Fundus photo. Image size 1932x1916.
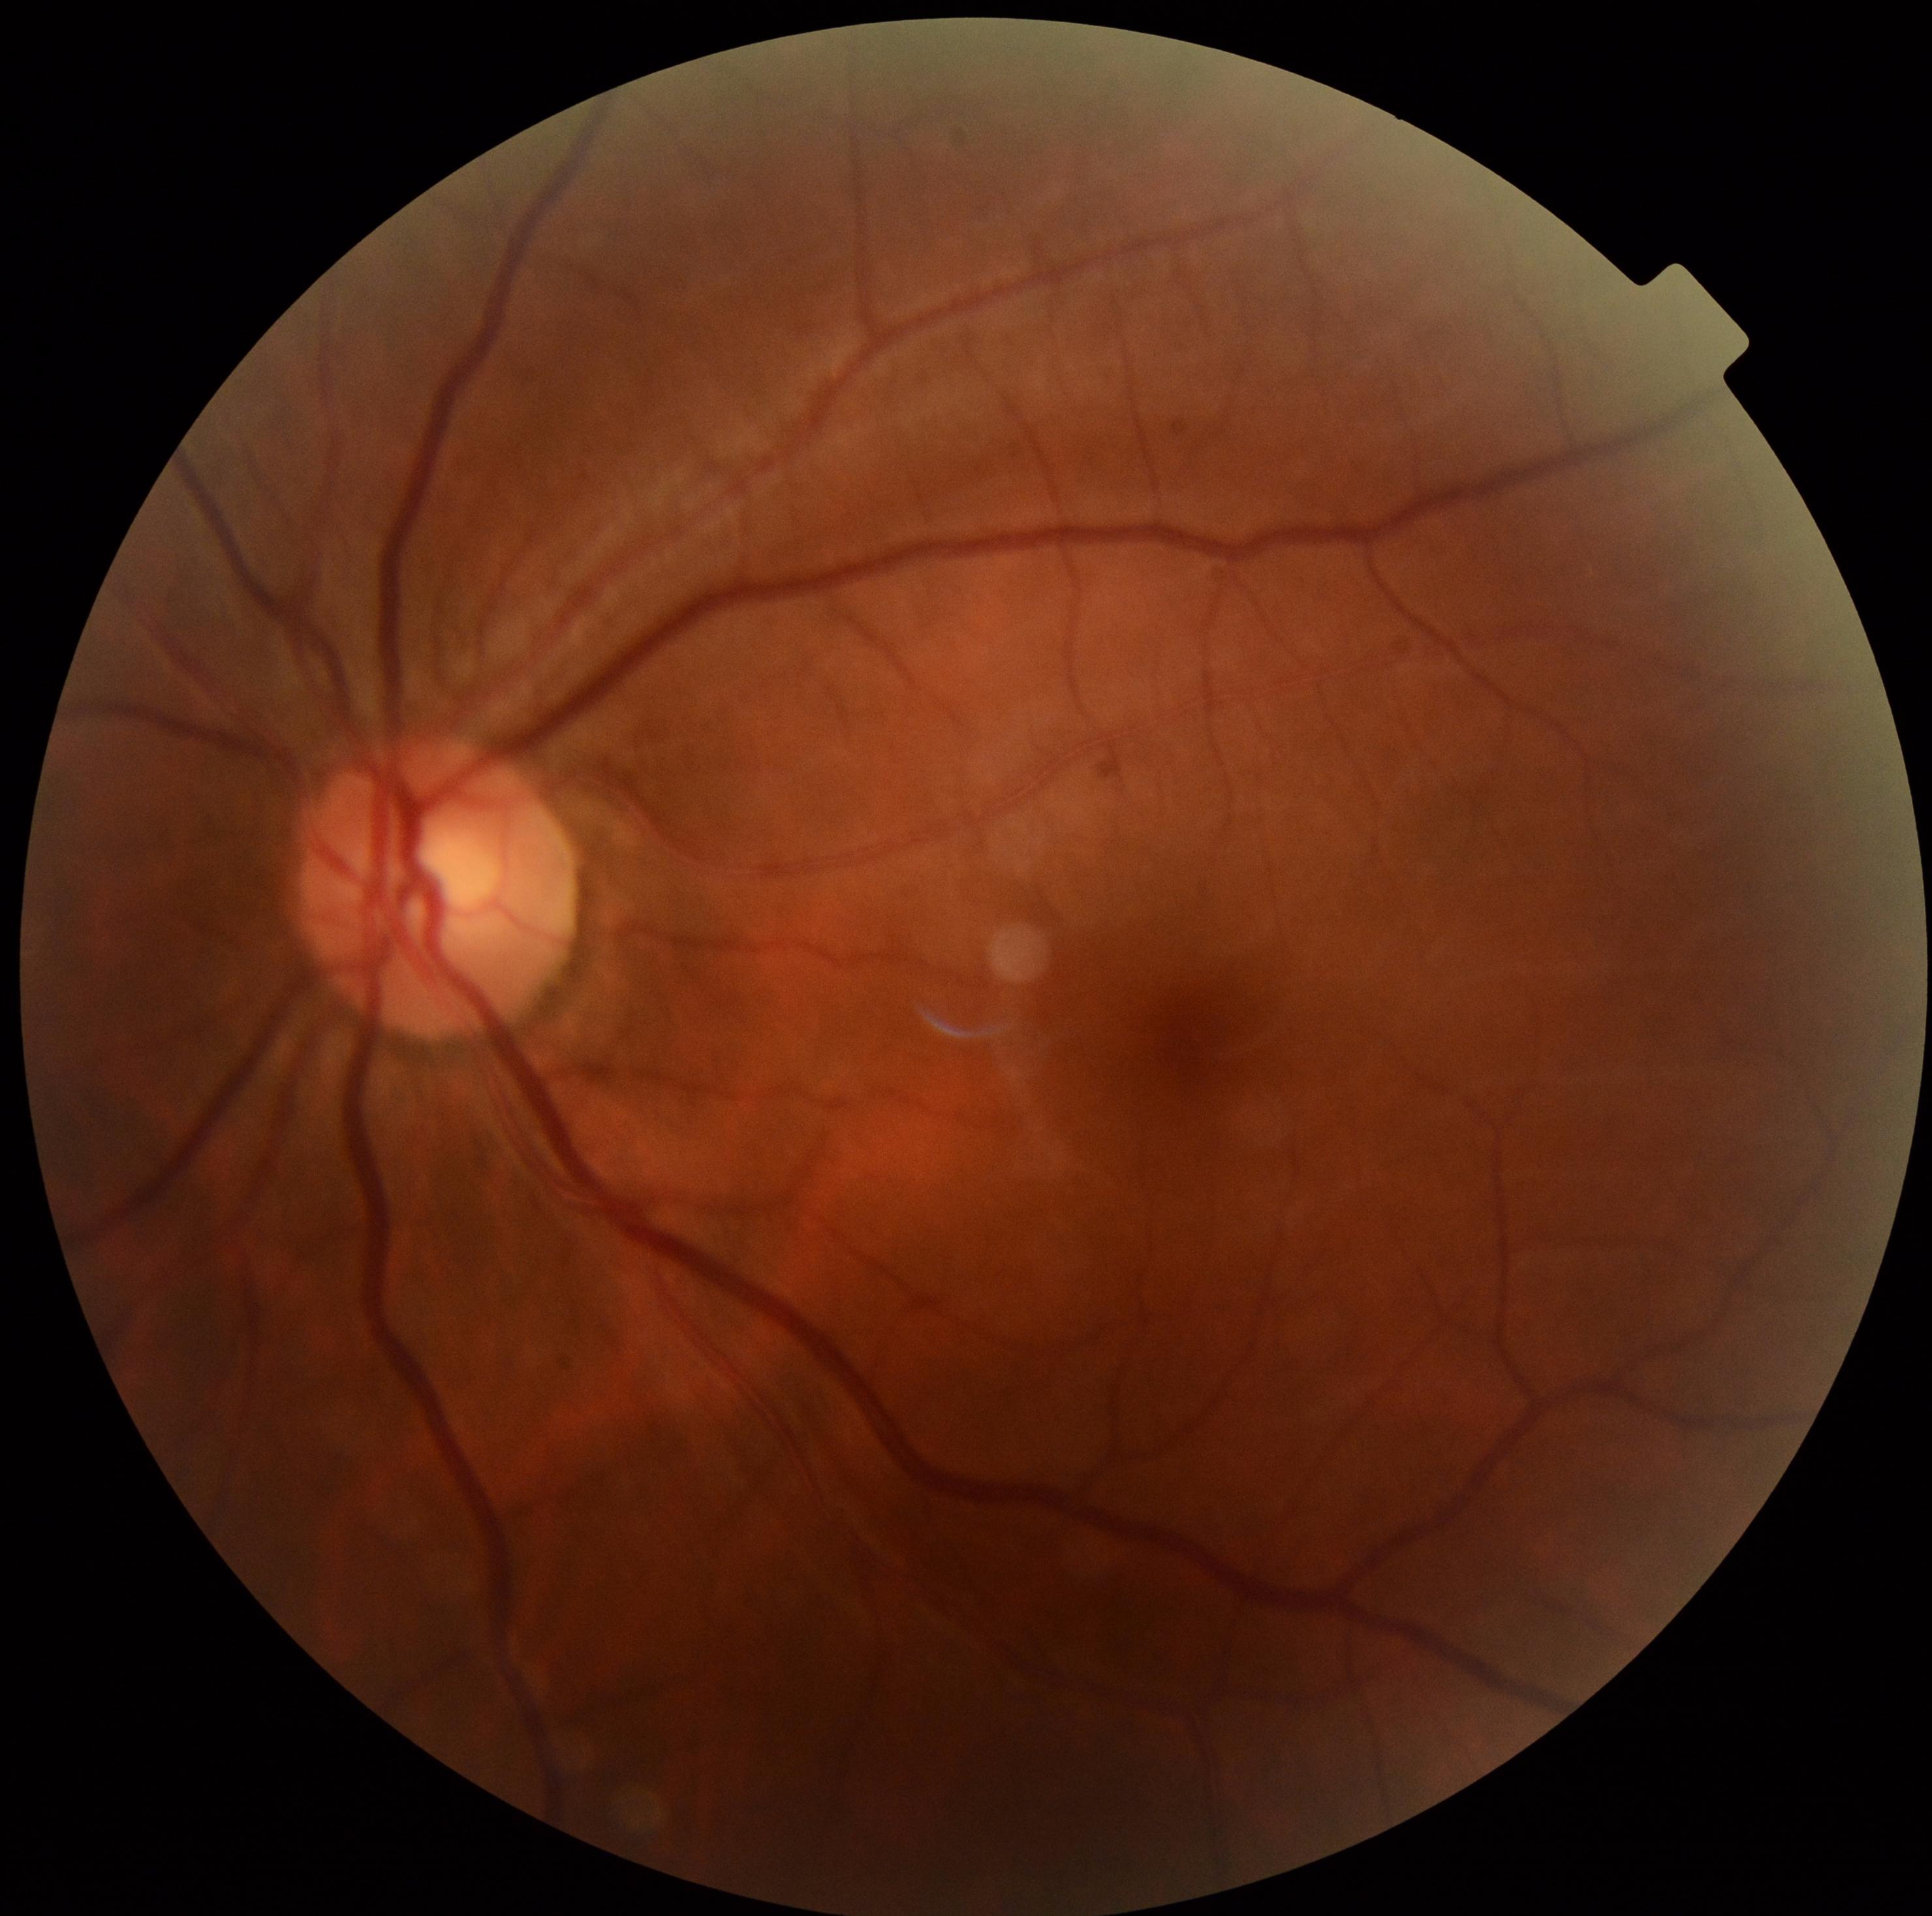
Diabetic retinopathy (DR) is 0/4.